Retinal fundus photograph — 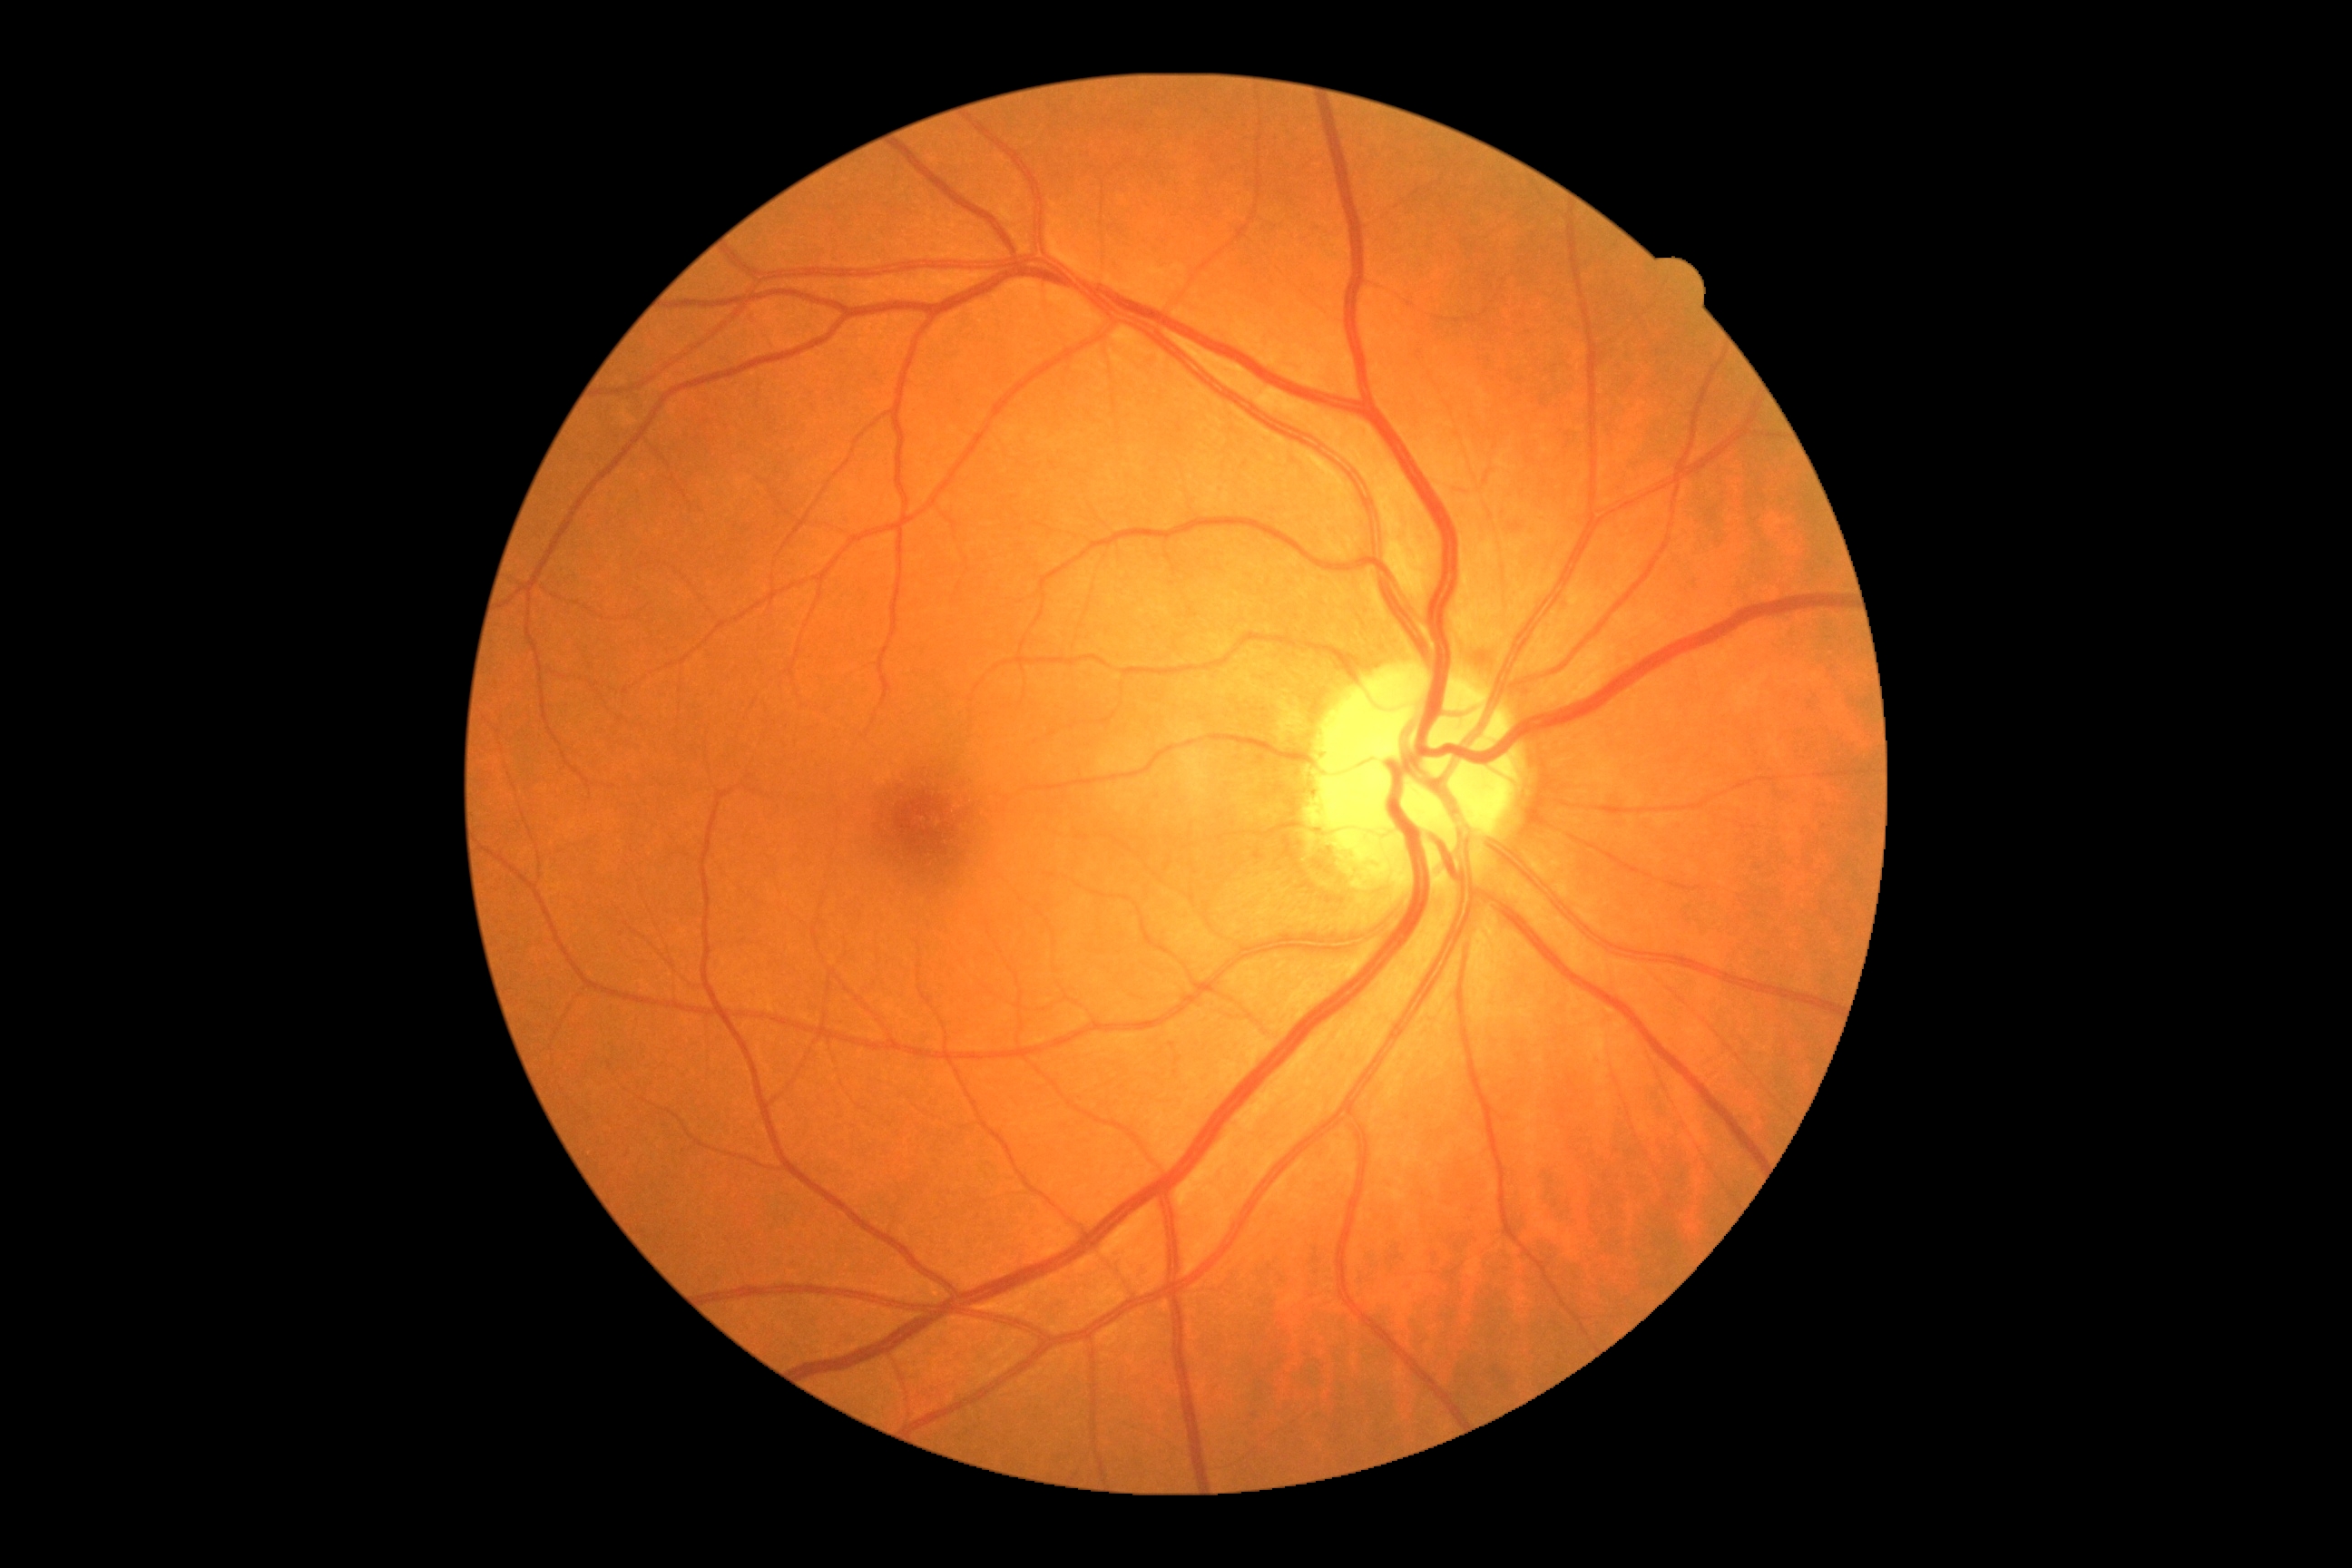 diabetic retinopathy (DR): grade 0 (no apparent retinopathy).